Infant wide-field retinal image: 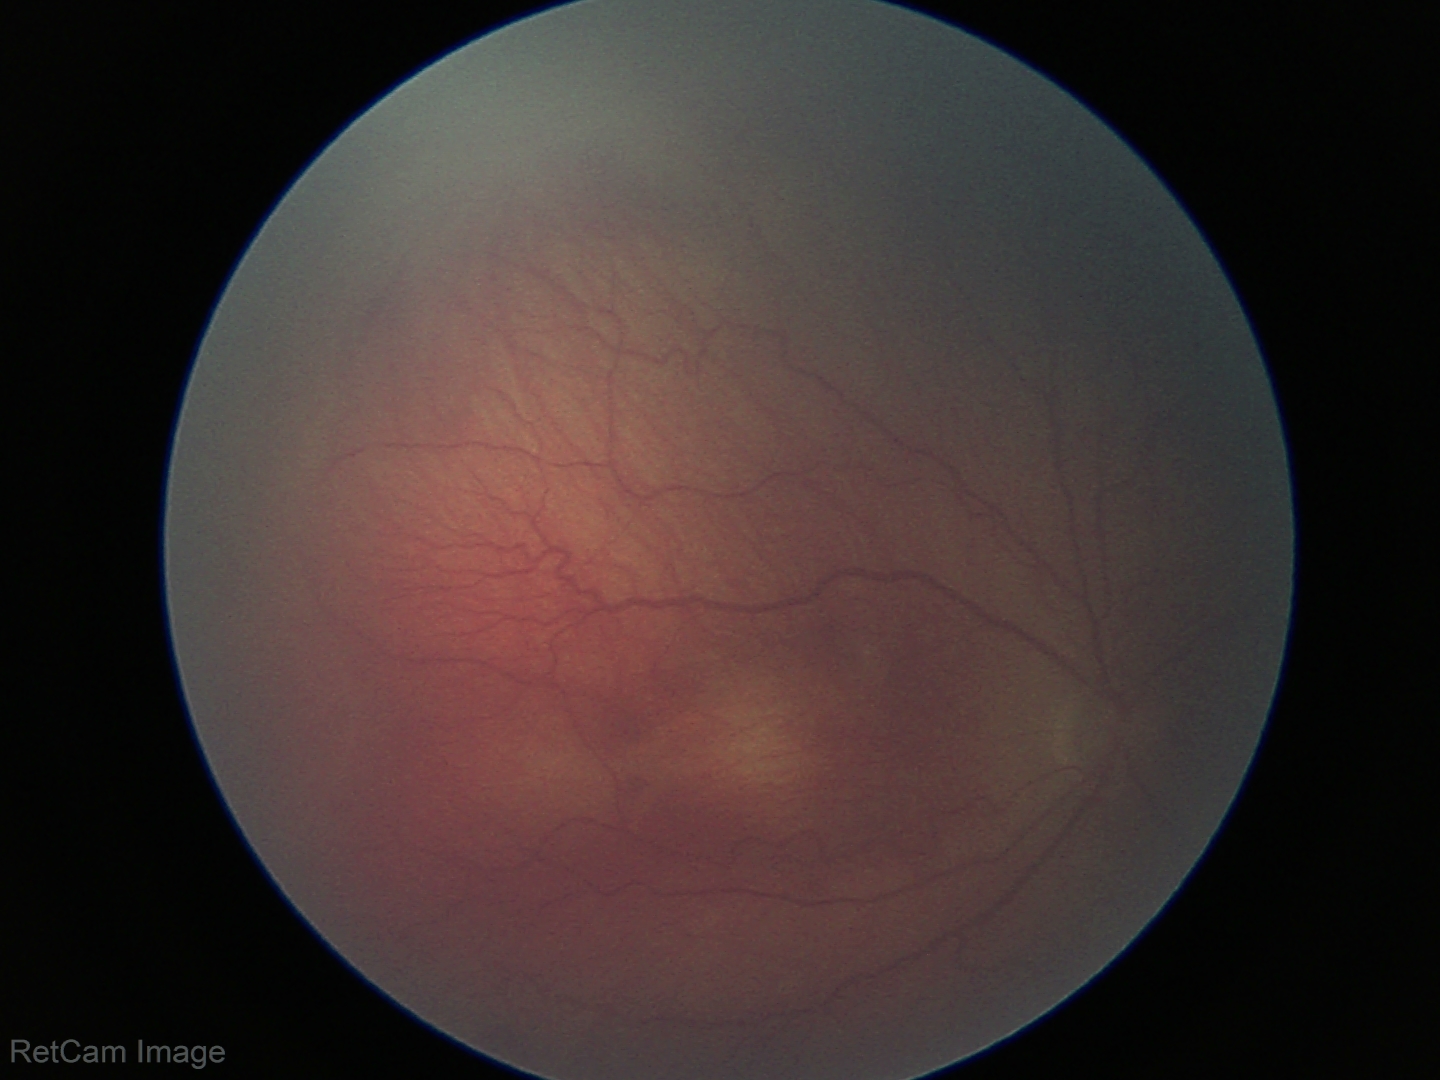 Impression = retinopathy of prematurity (ROP) stage 2 | plus form = absent.